Color fundus photograph from a handheld portable camera. 60° FOV:
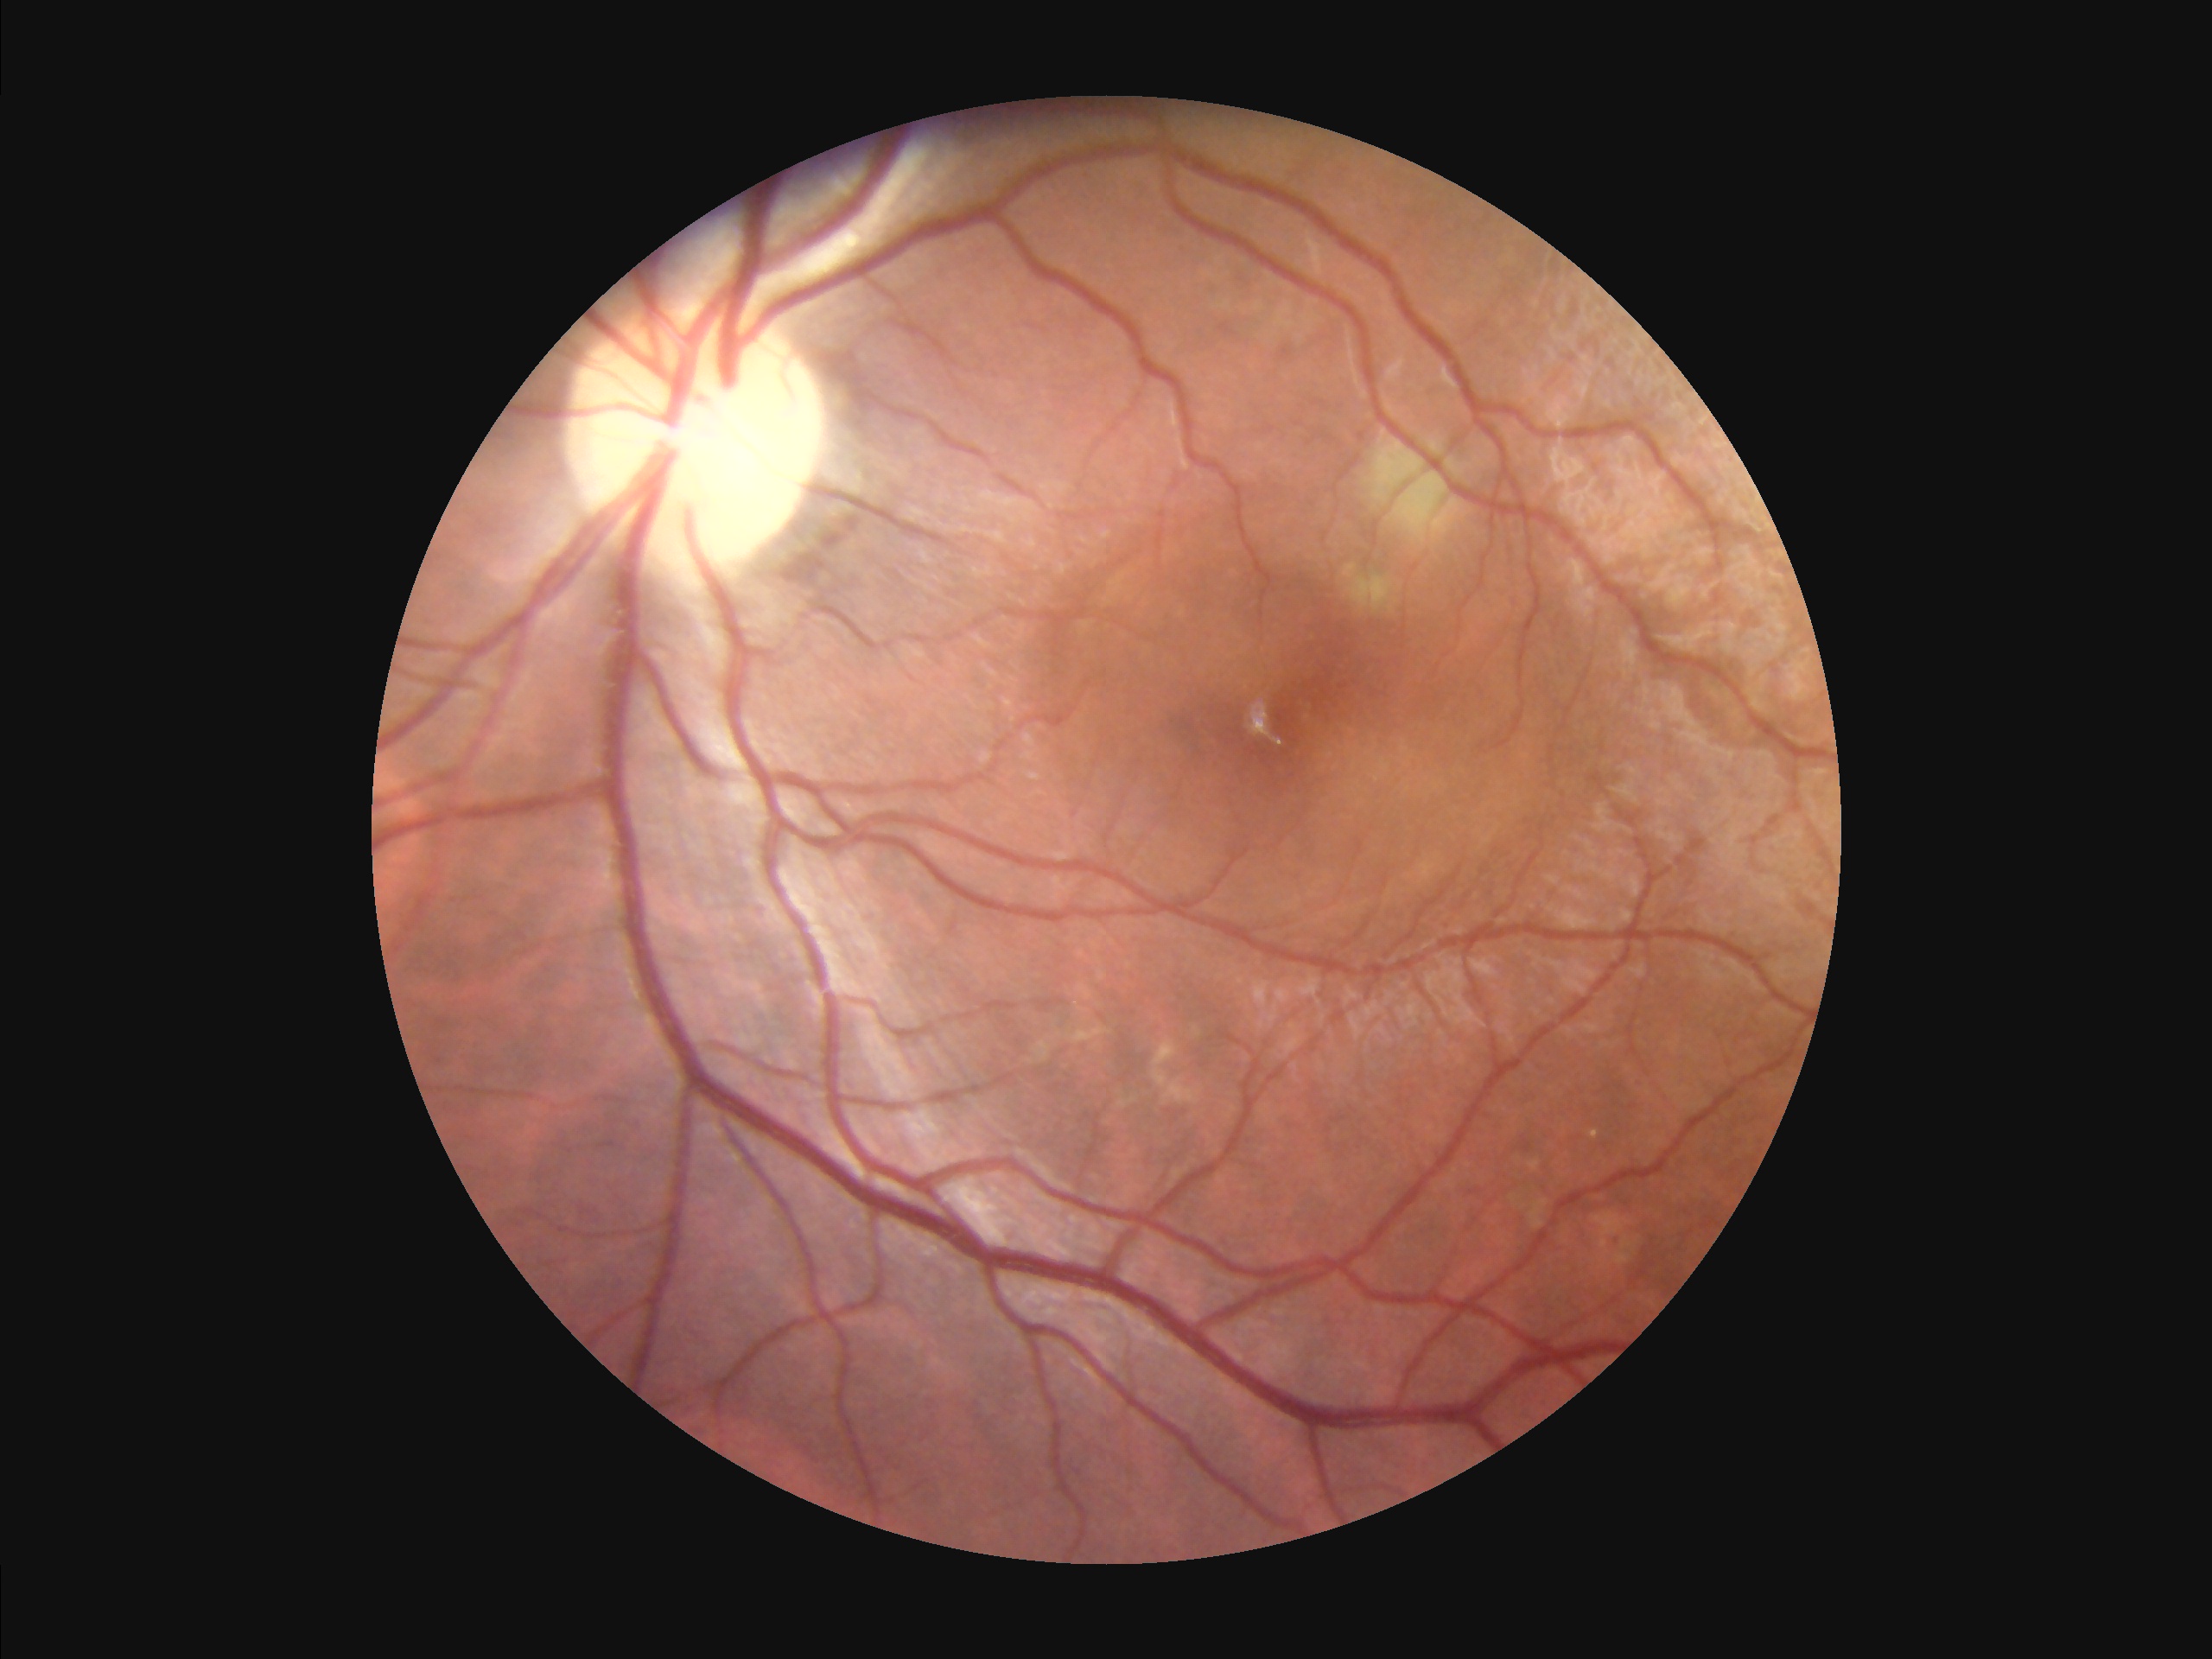

illumination: adequate
contrast: adequate
overall_quality: satisfactory